Retinal fundus photograph; acquired with a NIDEK AFC-230
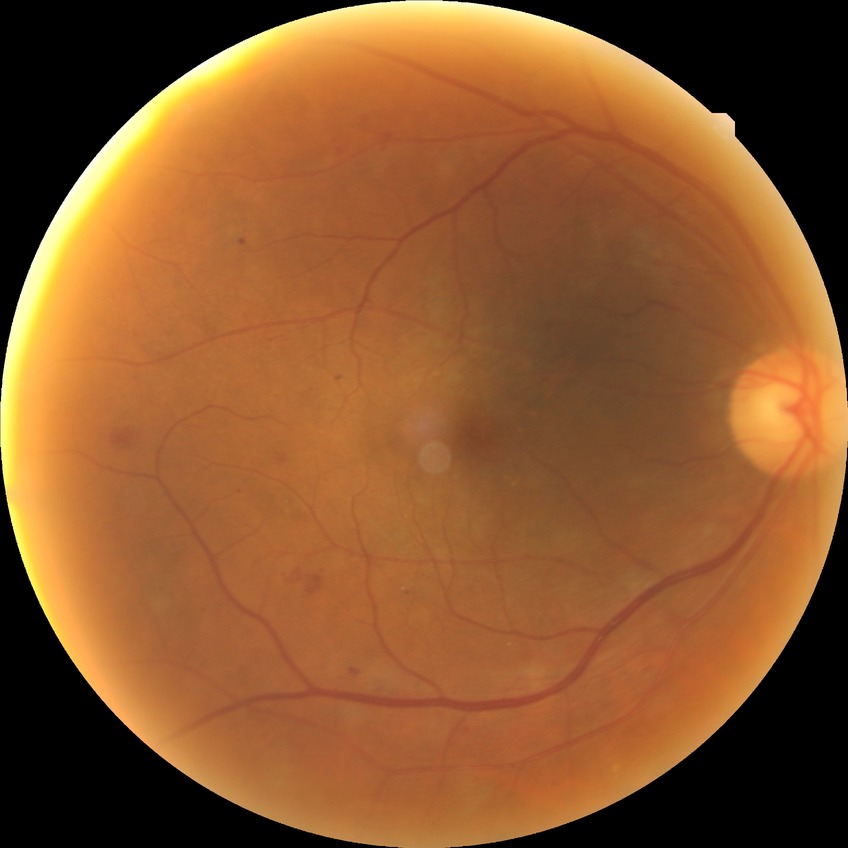 Diabetic retinopathy (DR) is SDR (simple diabetic retinopathy). The retinopathy is classified as non-proliferative diabetic retinopathy.